Posterior pole photograph. Nonmydriatic. 45-degree field of view — 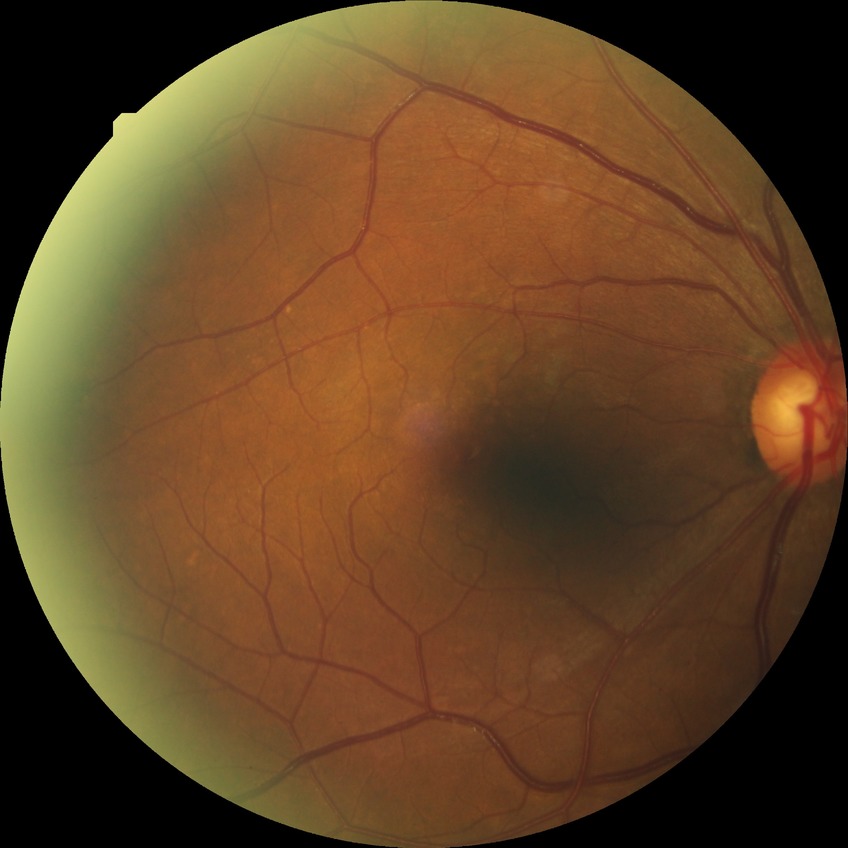 diabetic retinopathy (DR)=no diabetic retinopathy (NDR).